Camera: Phoenix ICON (100° FOV) · infant wide-field retinal image
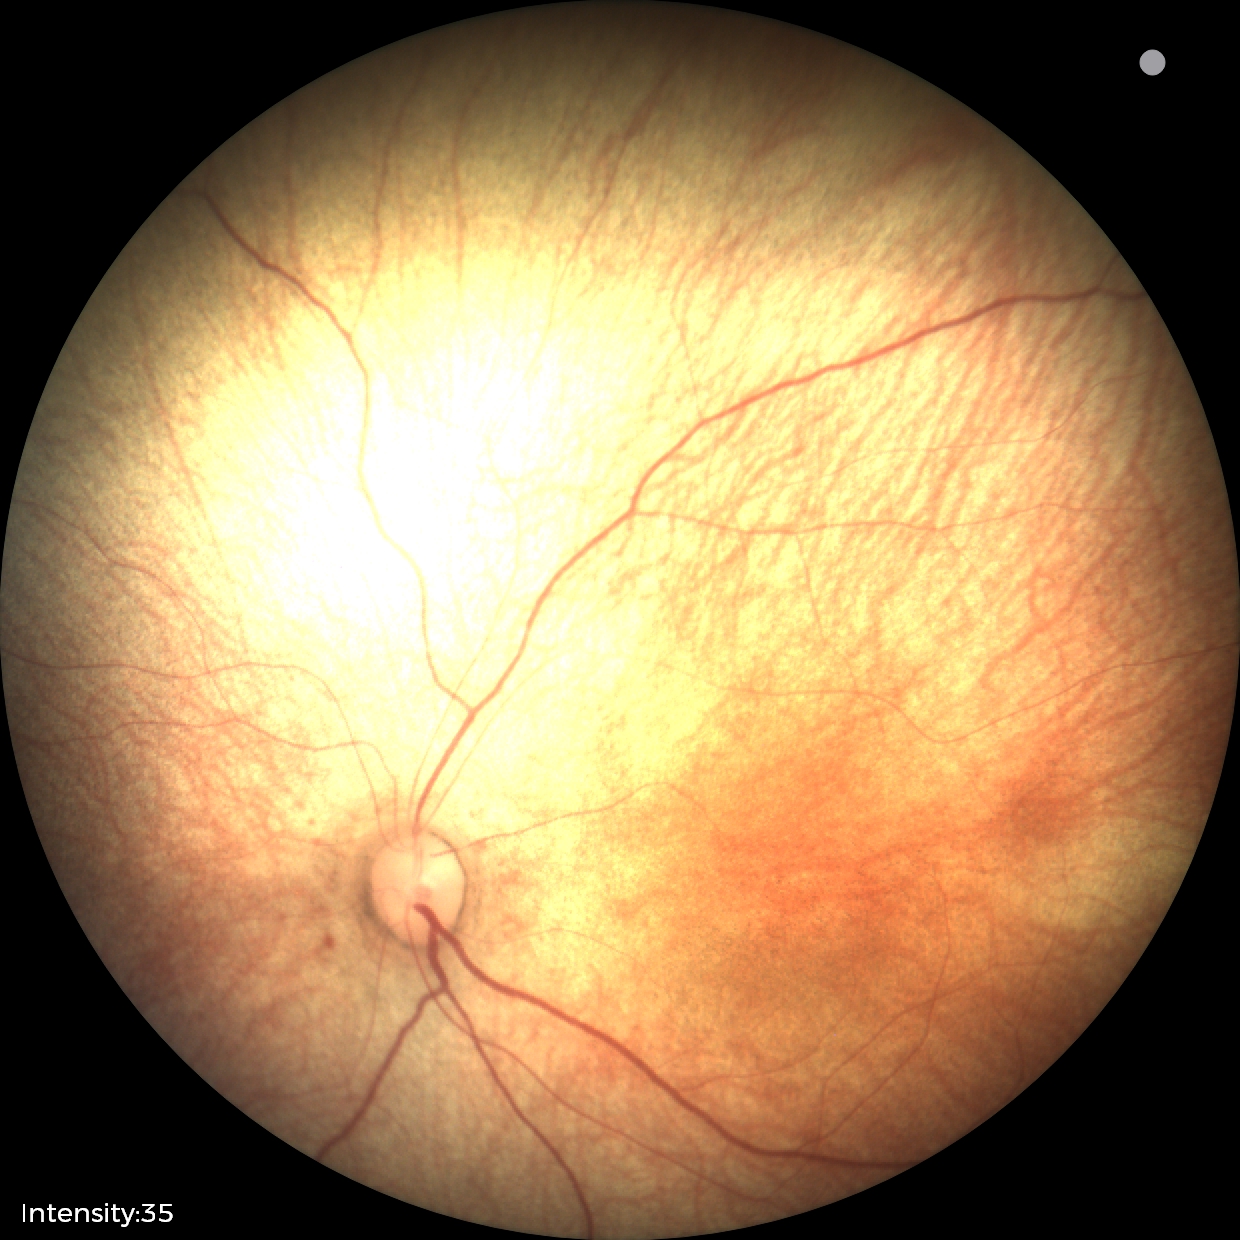

Screening examination diagnosed as physiological.